Image size 2352x1568 · FOV: 45 degrees.
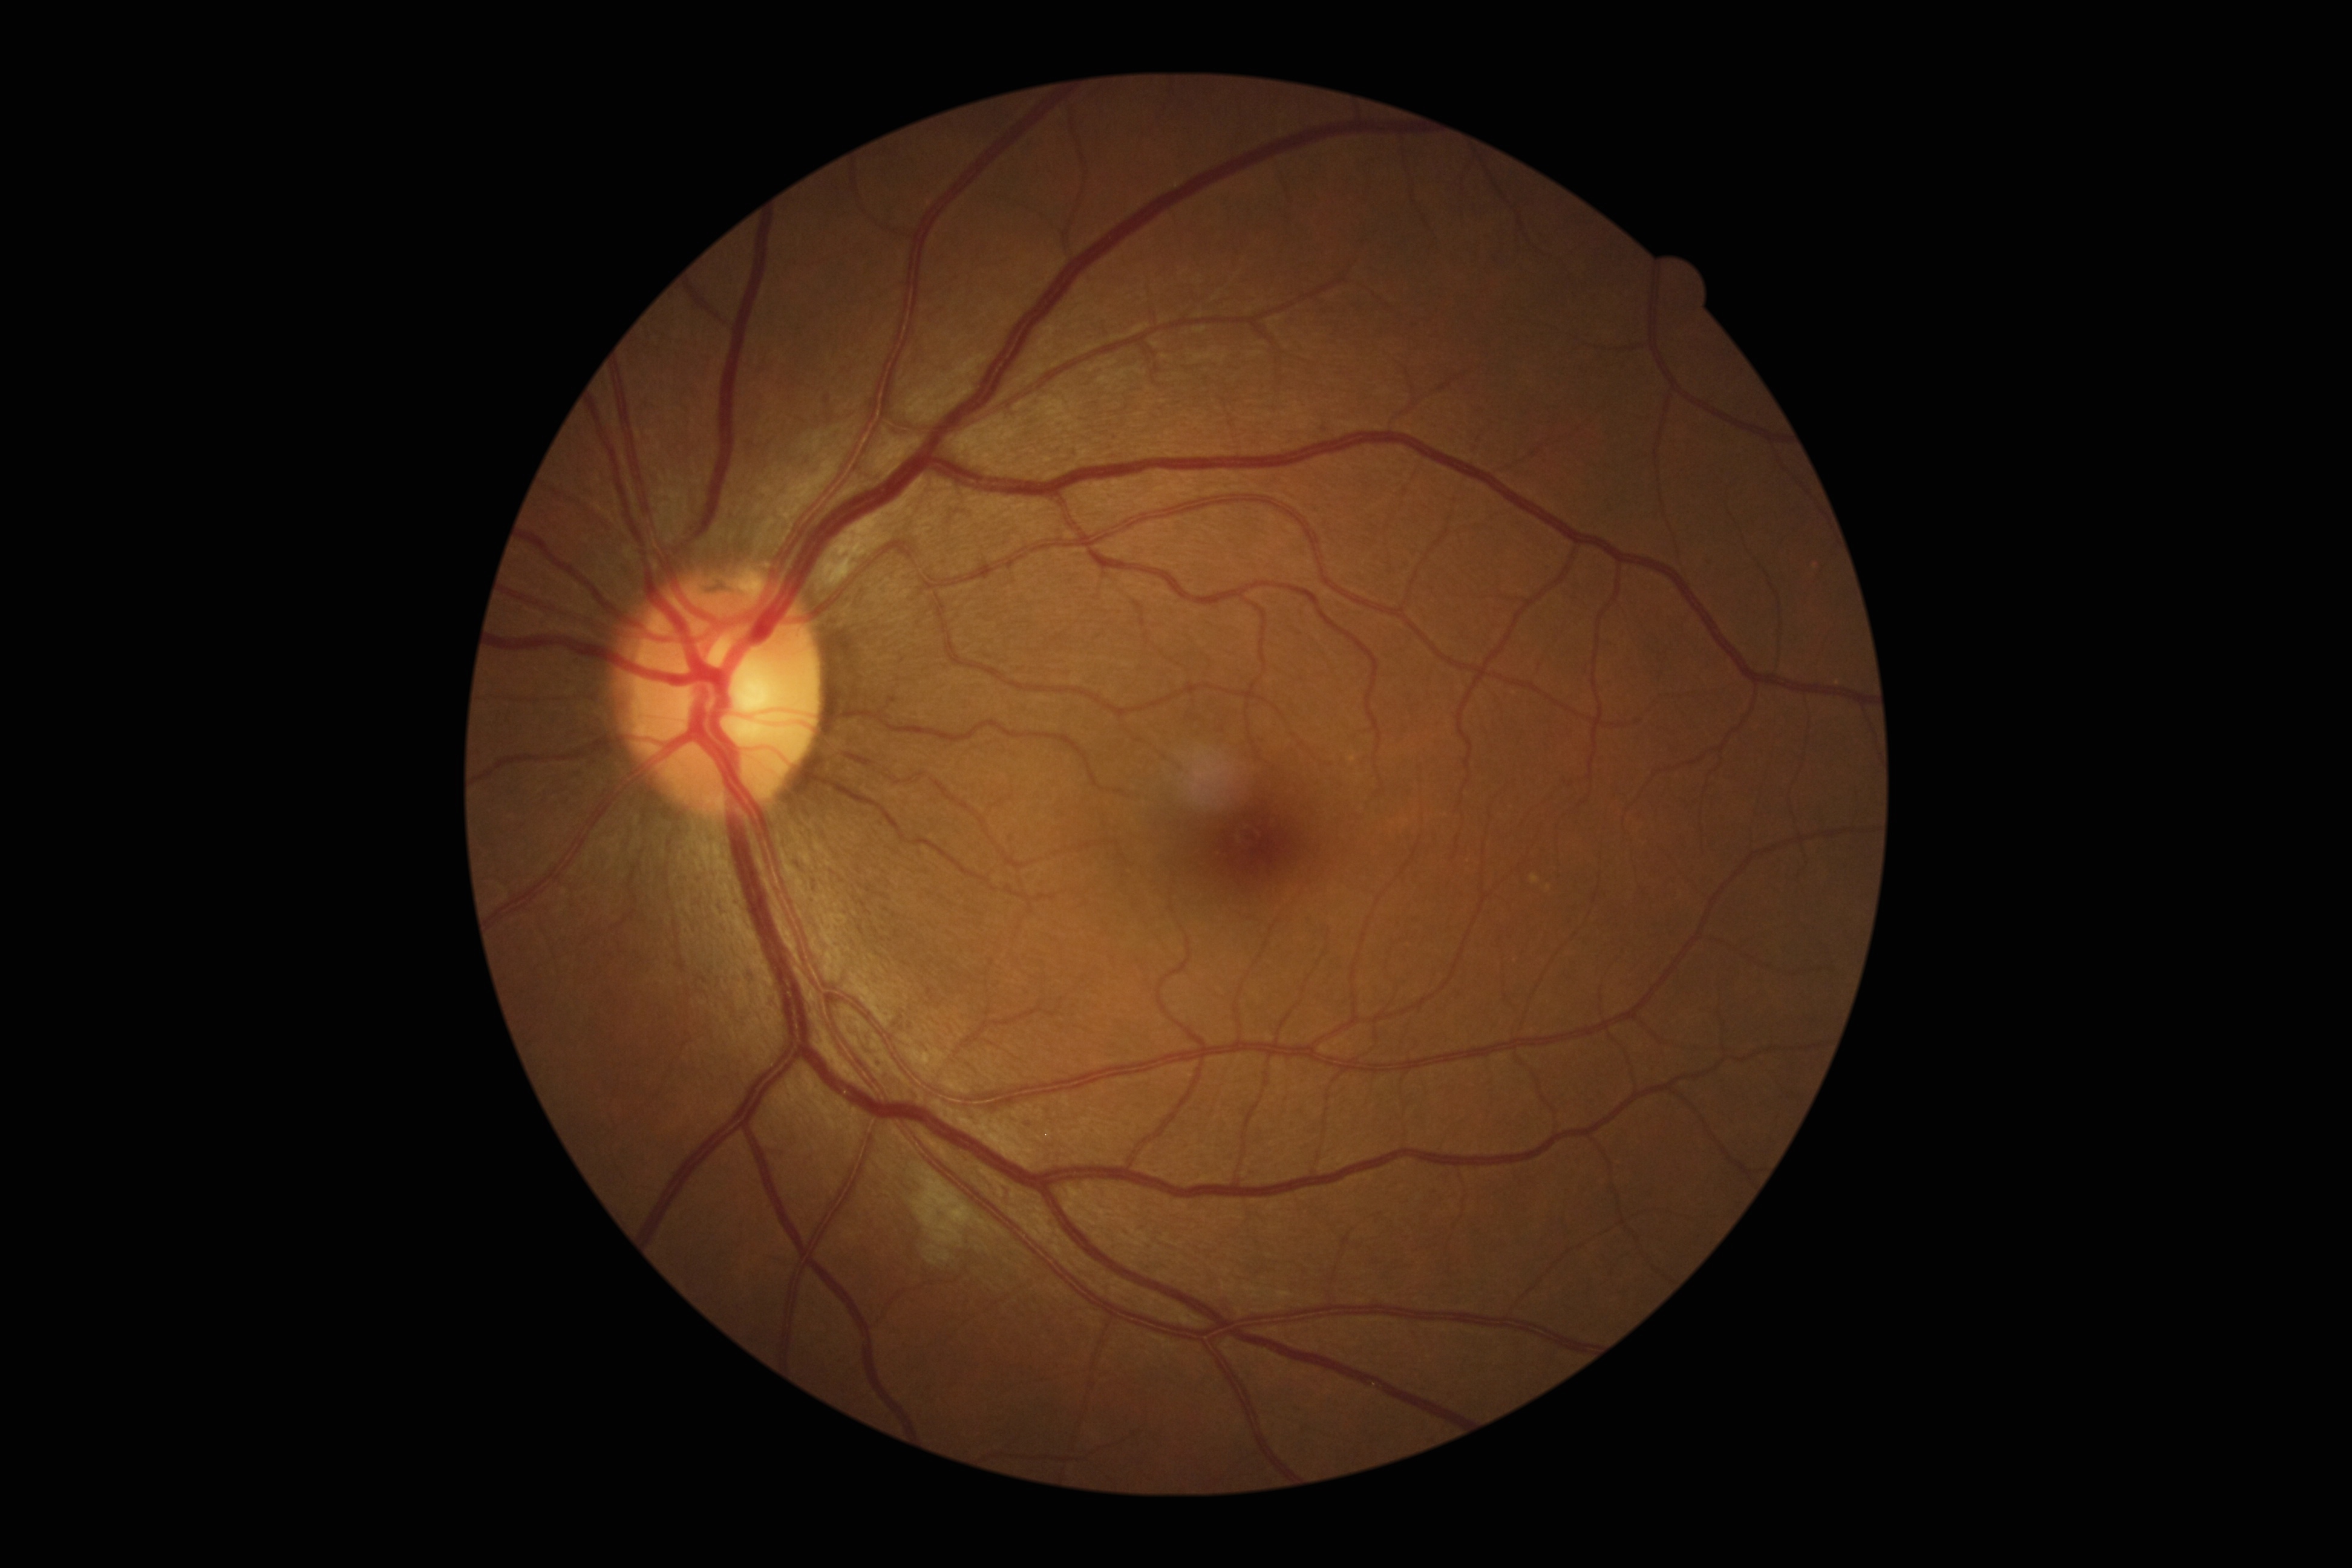 Retinopathy is moderate NPDR (grade 2).